640 by 480 pixels · wide-field contact fundus photograph of an infant
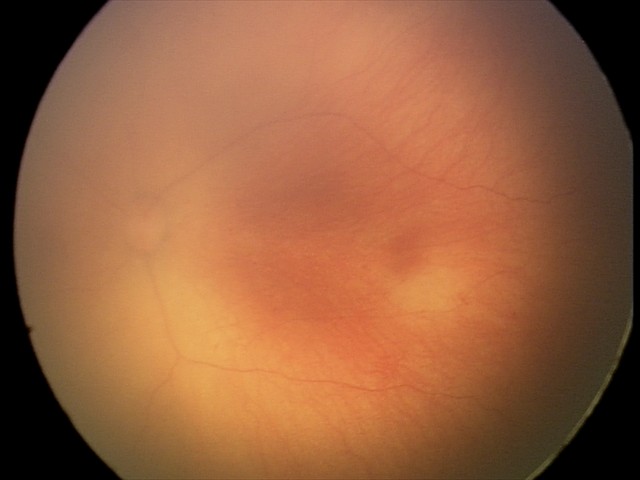

From an examination with diagnosis of ROP stage 0.